Camera: Natus RetCam Envision (130° FOV). Infant wide-field retinal image: 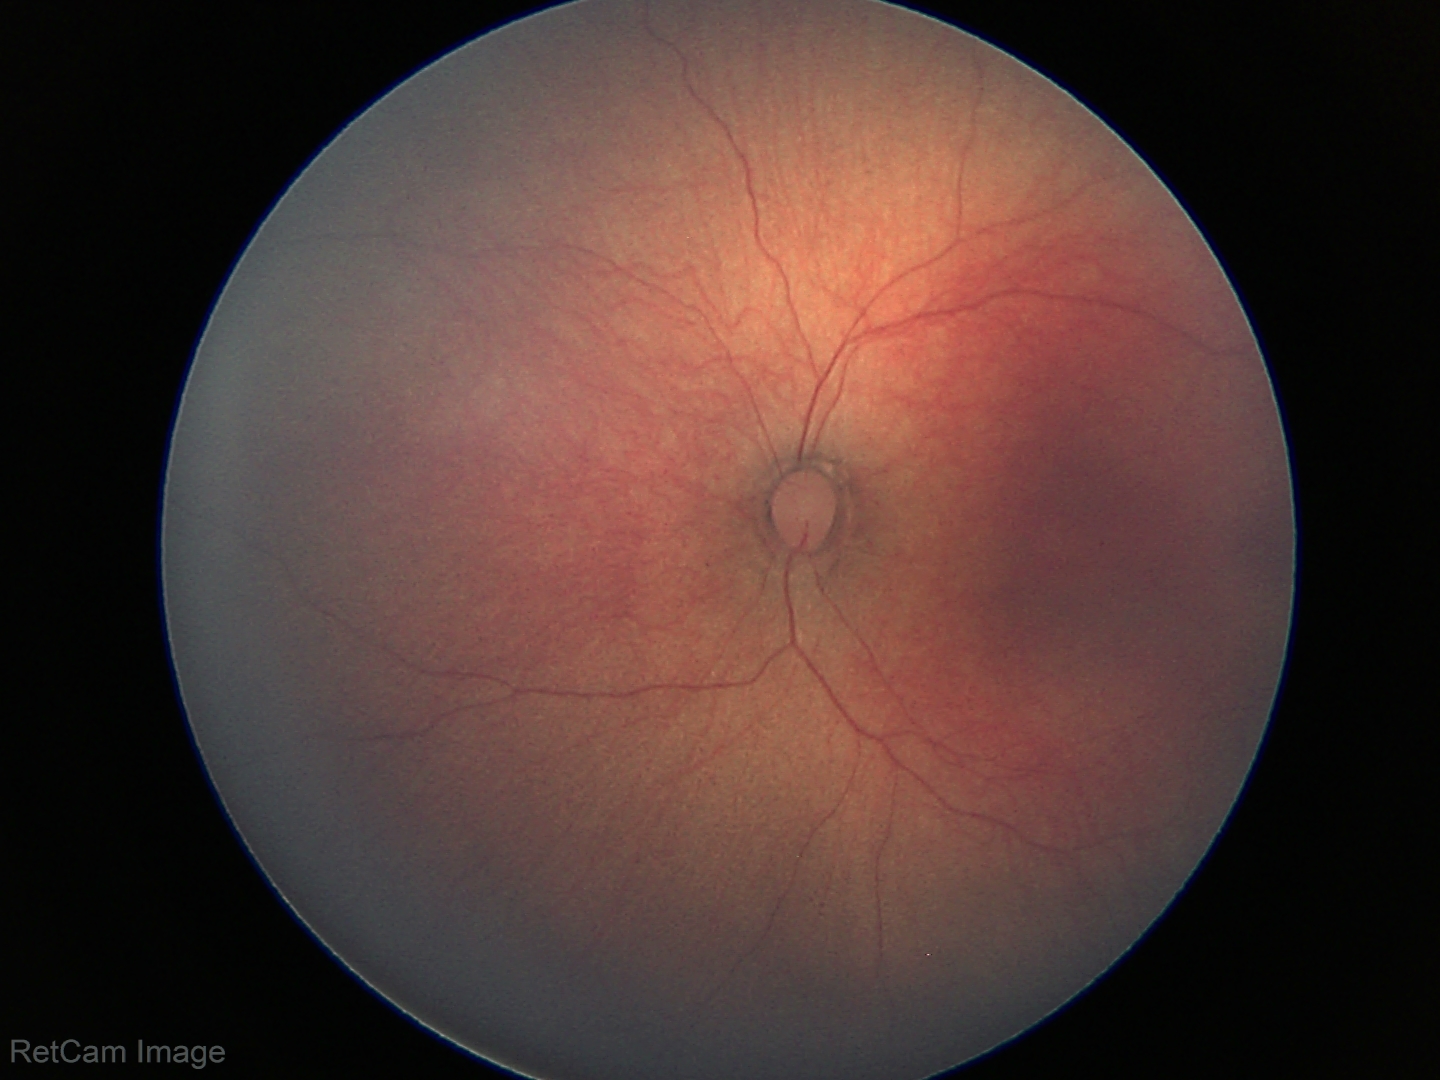 Normal screening examination.